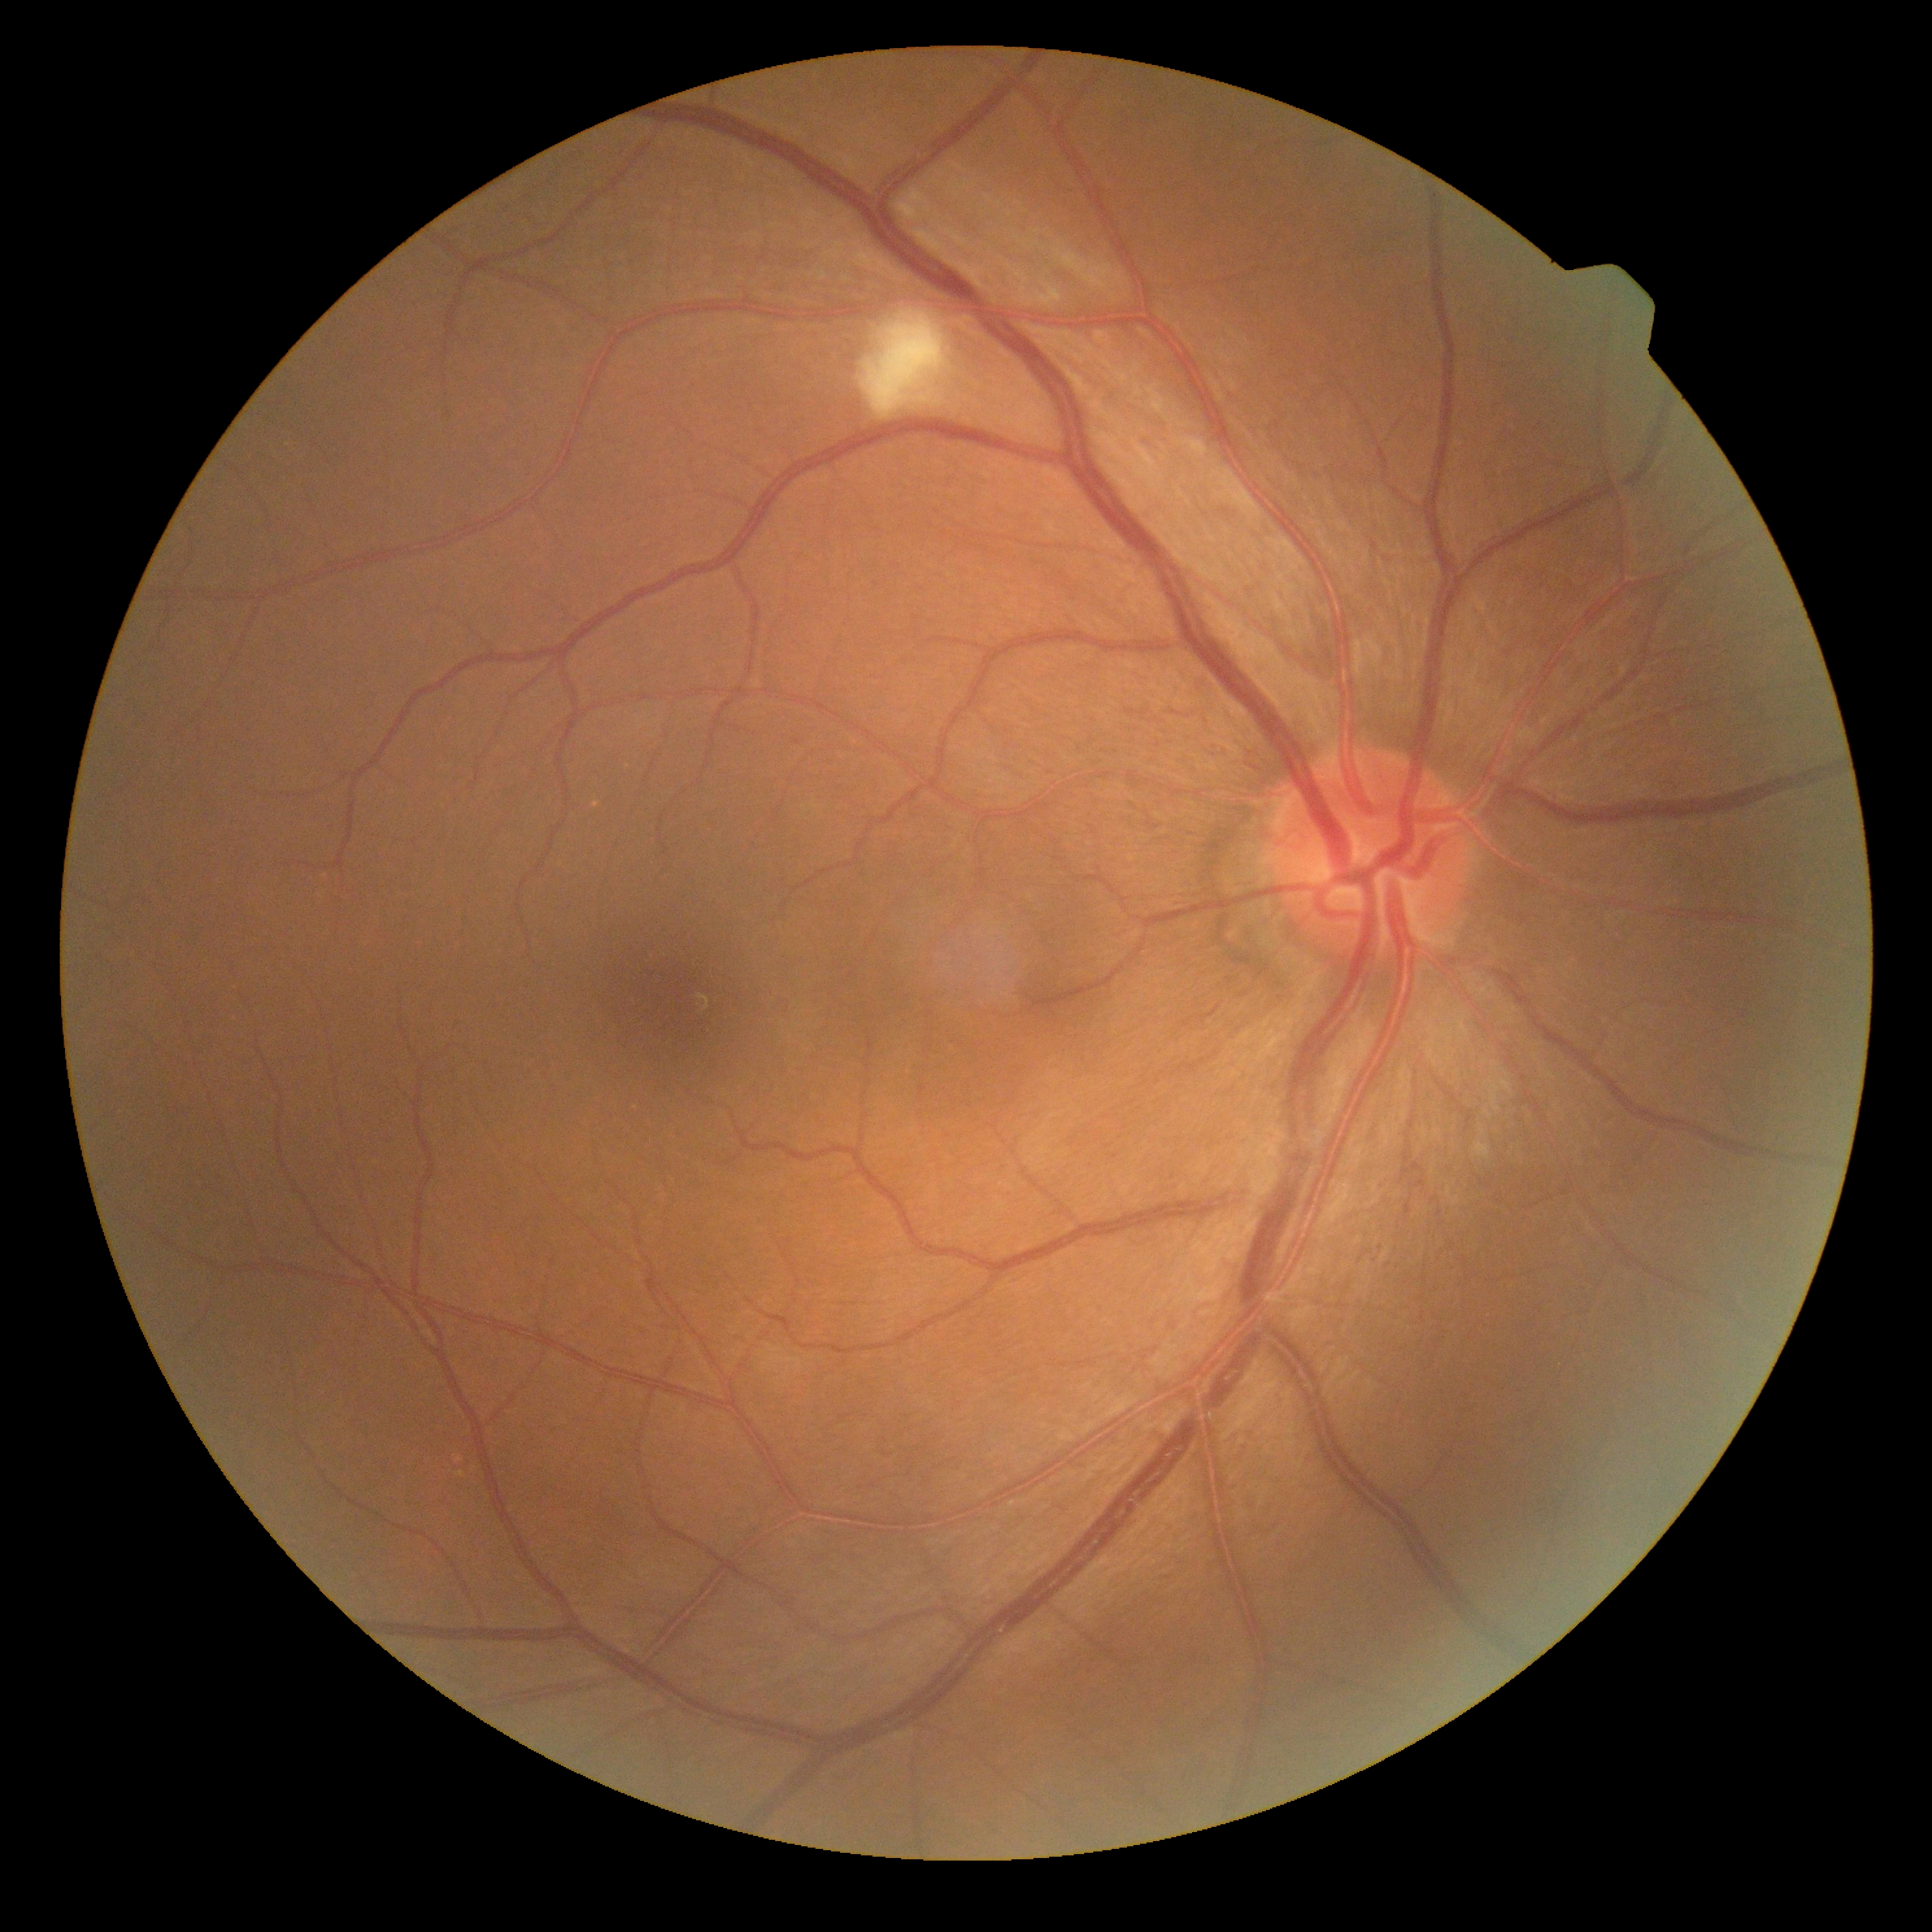

Diabetic retinopathy: moderate non-proliferative diabetic retinopathy (grade 2).